Fundus photo — 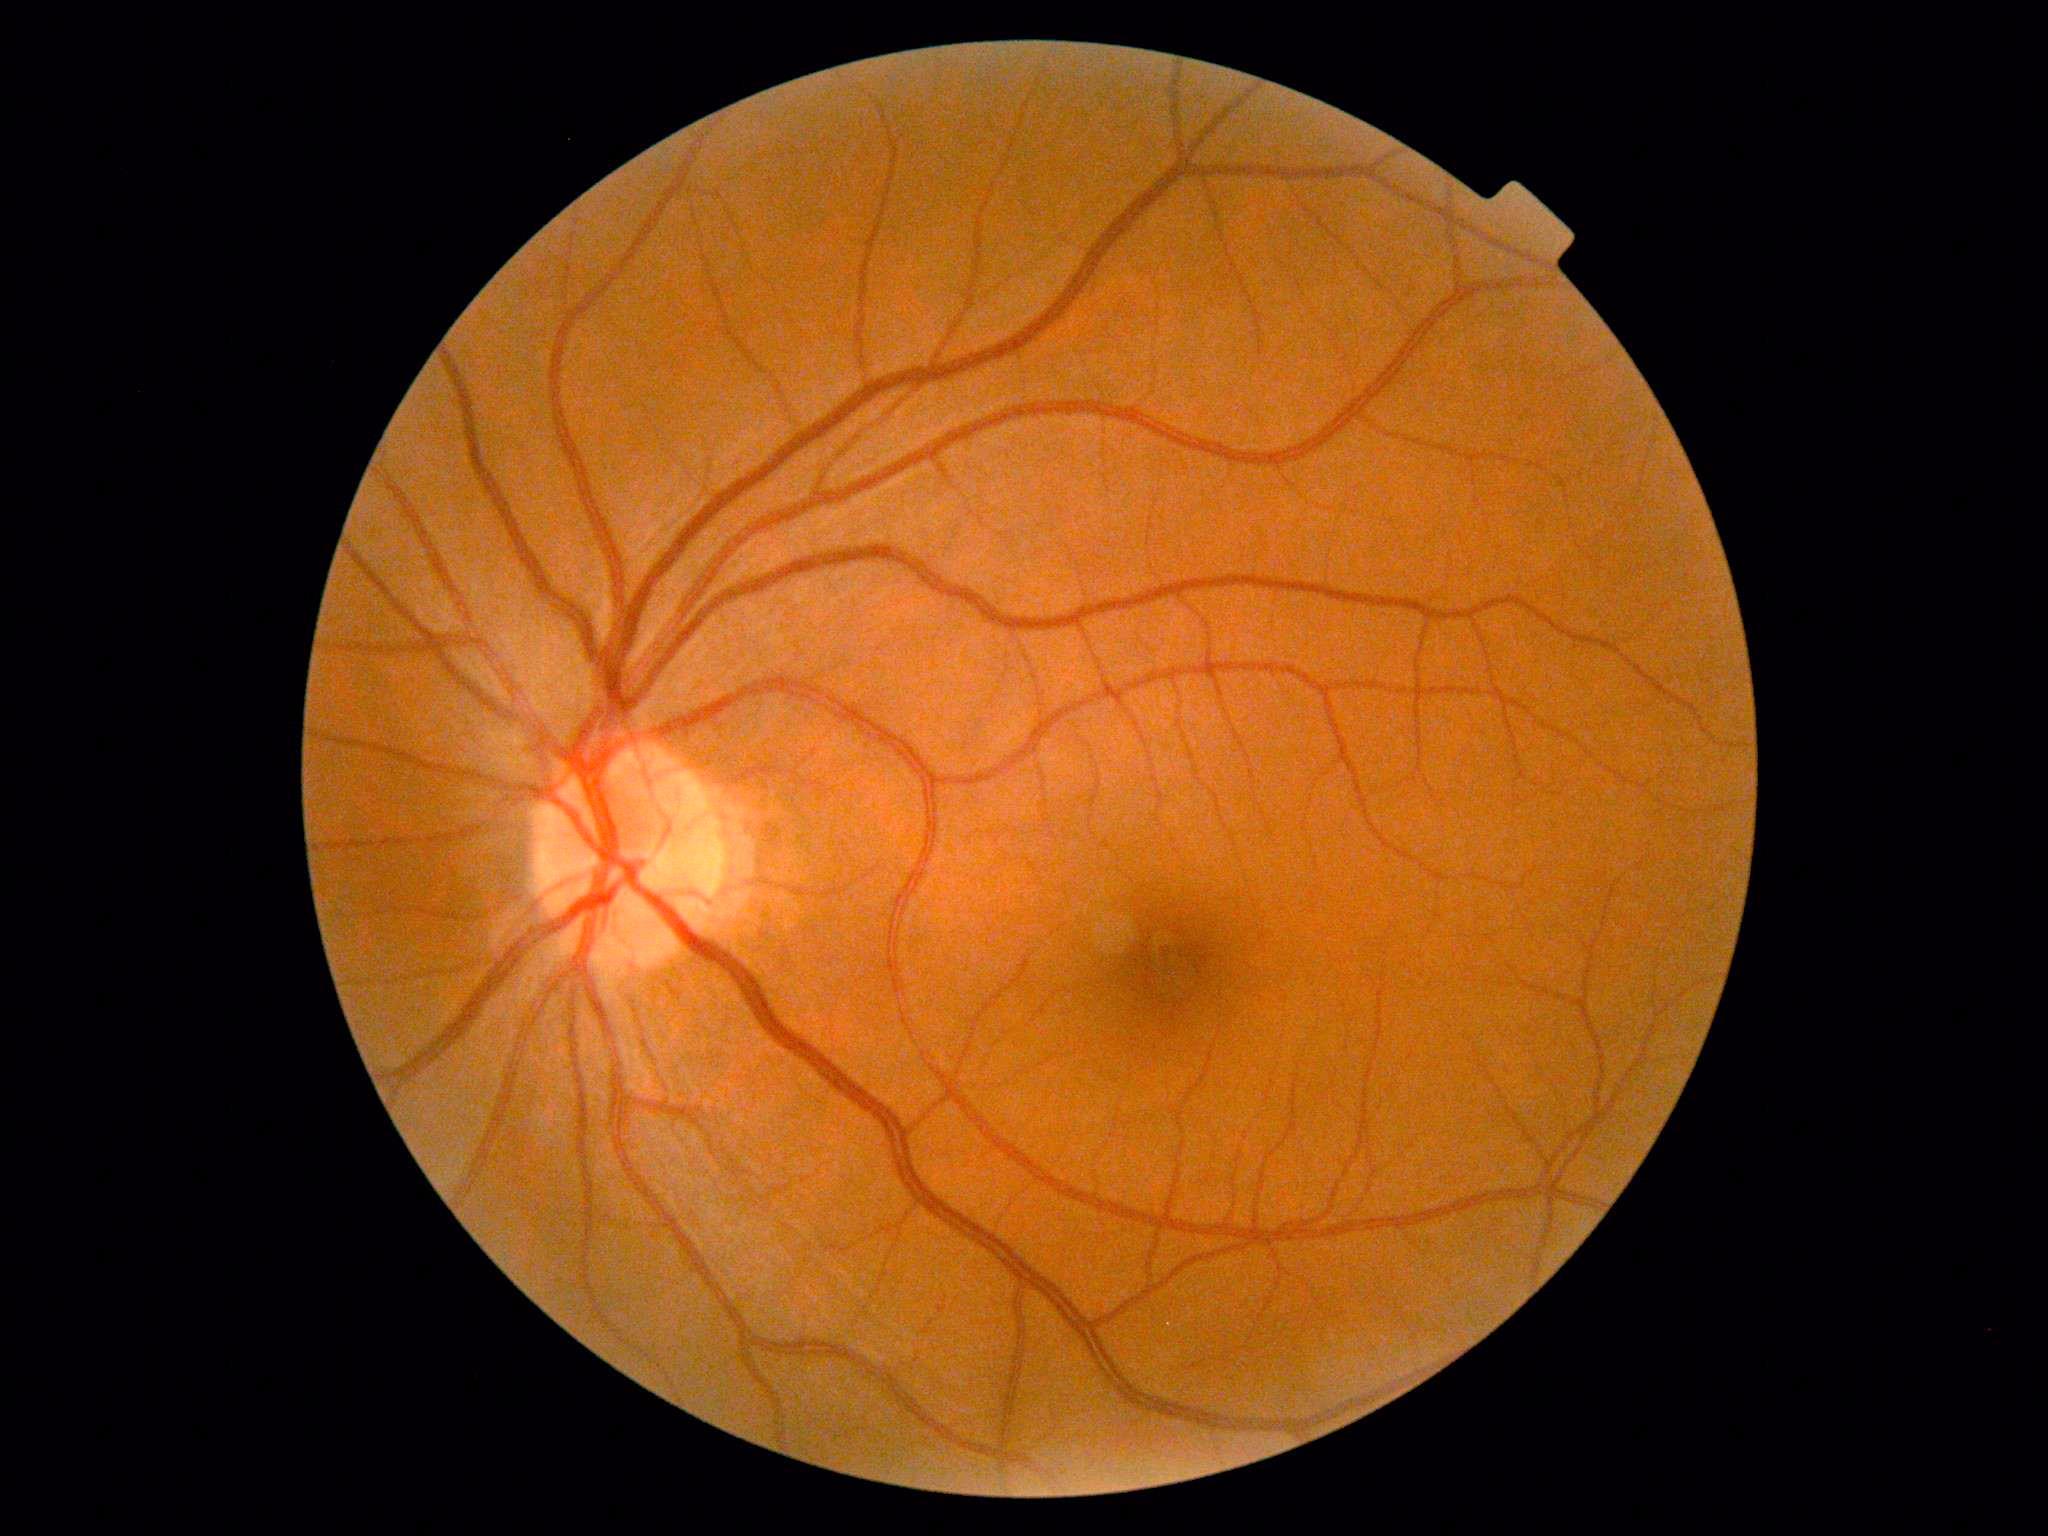

DR severity: grade 0 (no apparent retinopathy).
No apparent diabetic retinopathy.